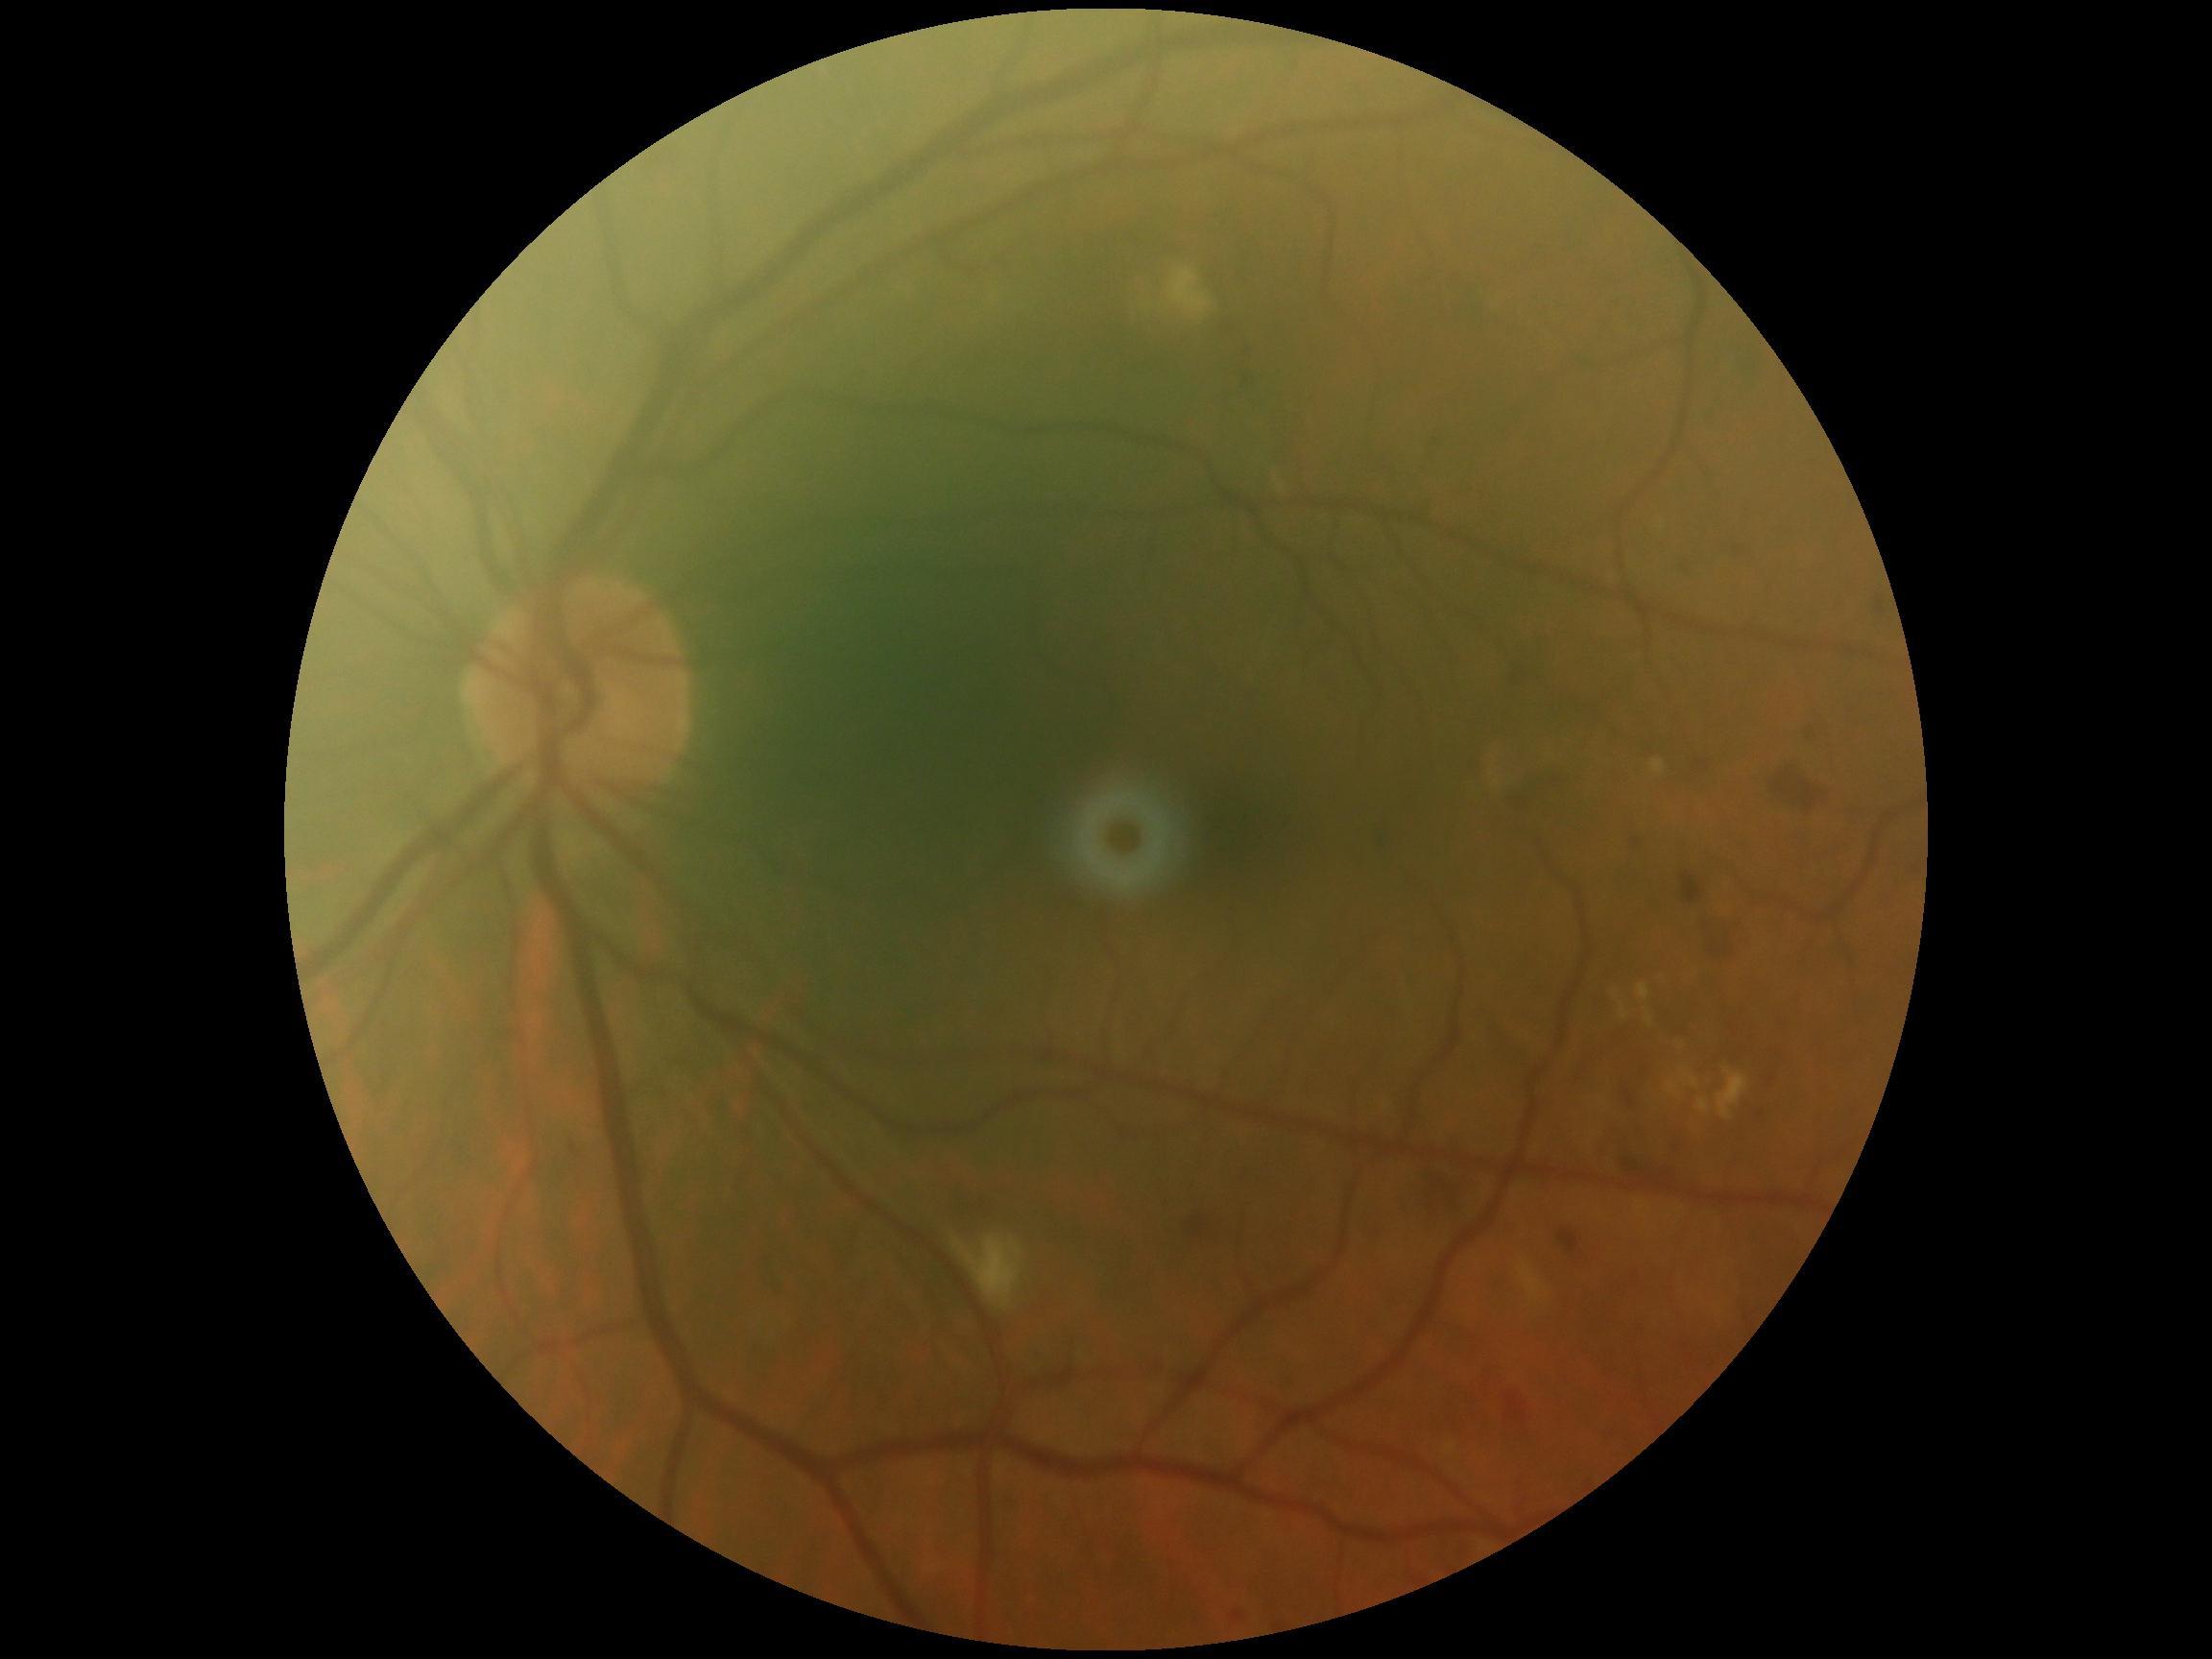 diabetic retinopathy (DR) = grade 2; DR class = non-proliferative diabetic retinopathy.